2048 x 1536 pixels:
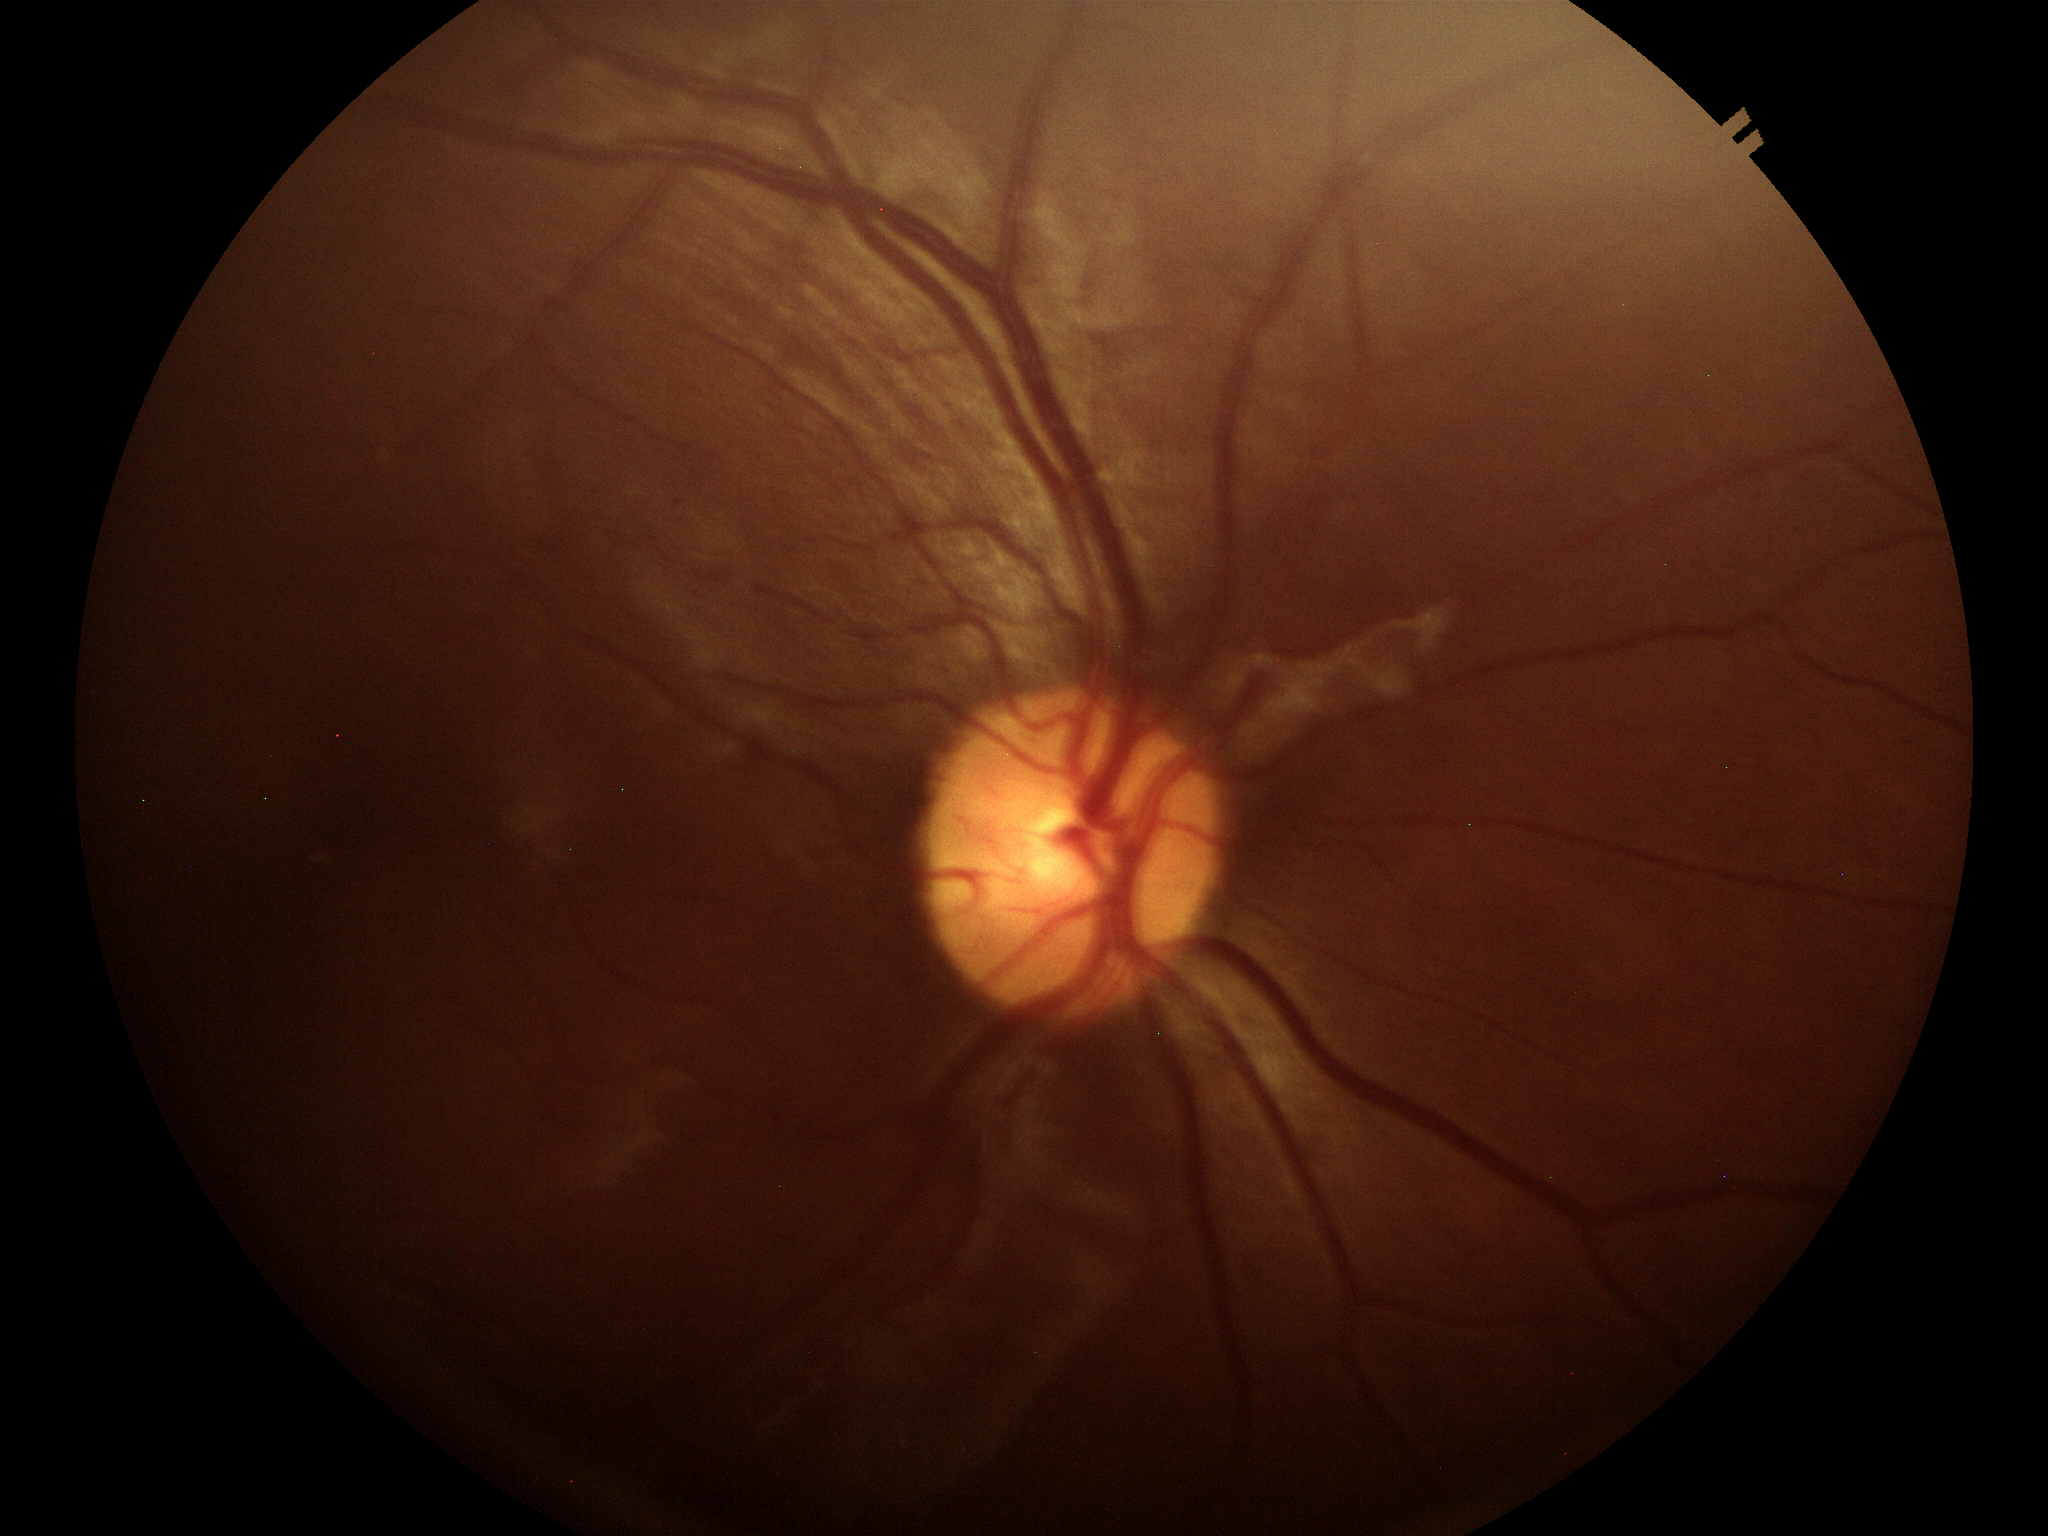
horizontal cup-disc ratio (HCDR) = 0.44, vertical C/D ratio (VCDR) = 0.44, Glaucoma evaluation = no suspicious findings.